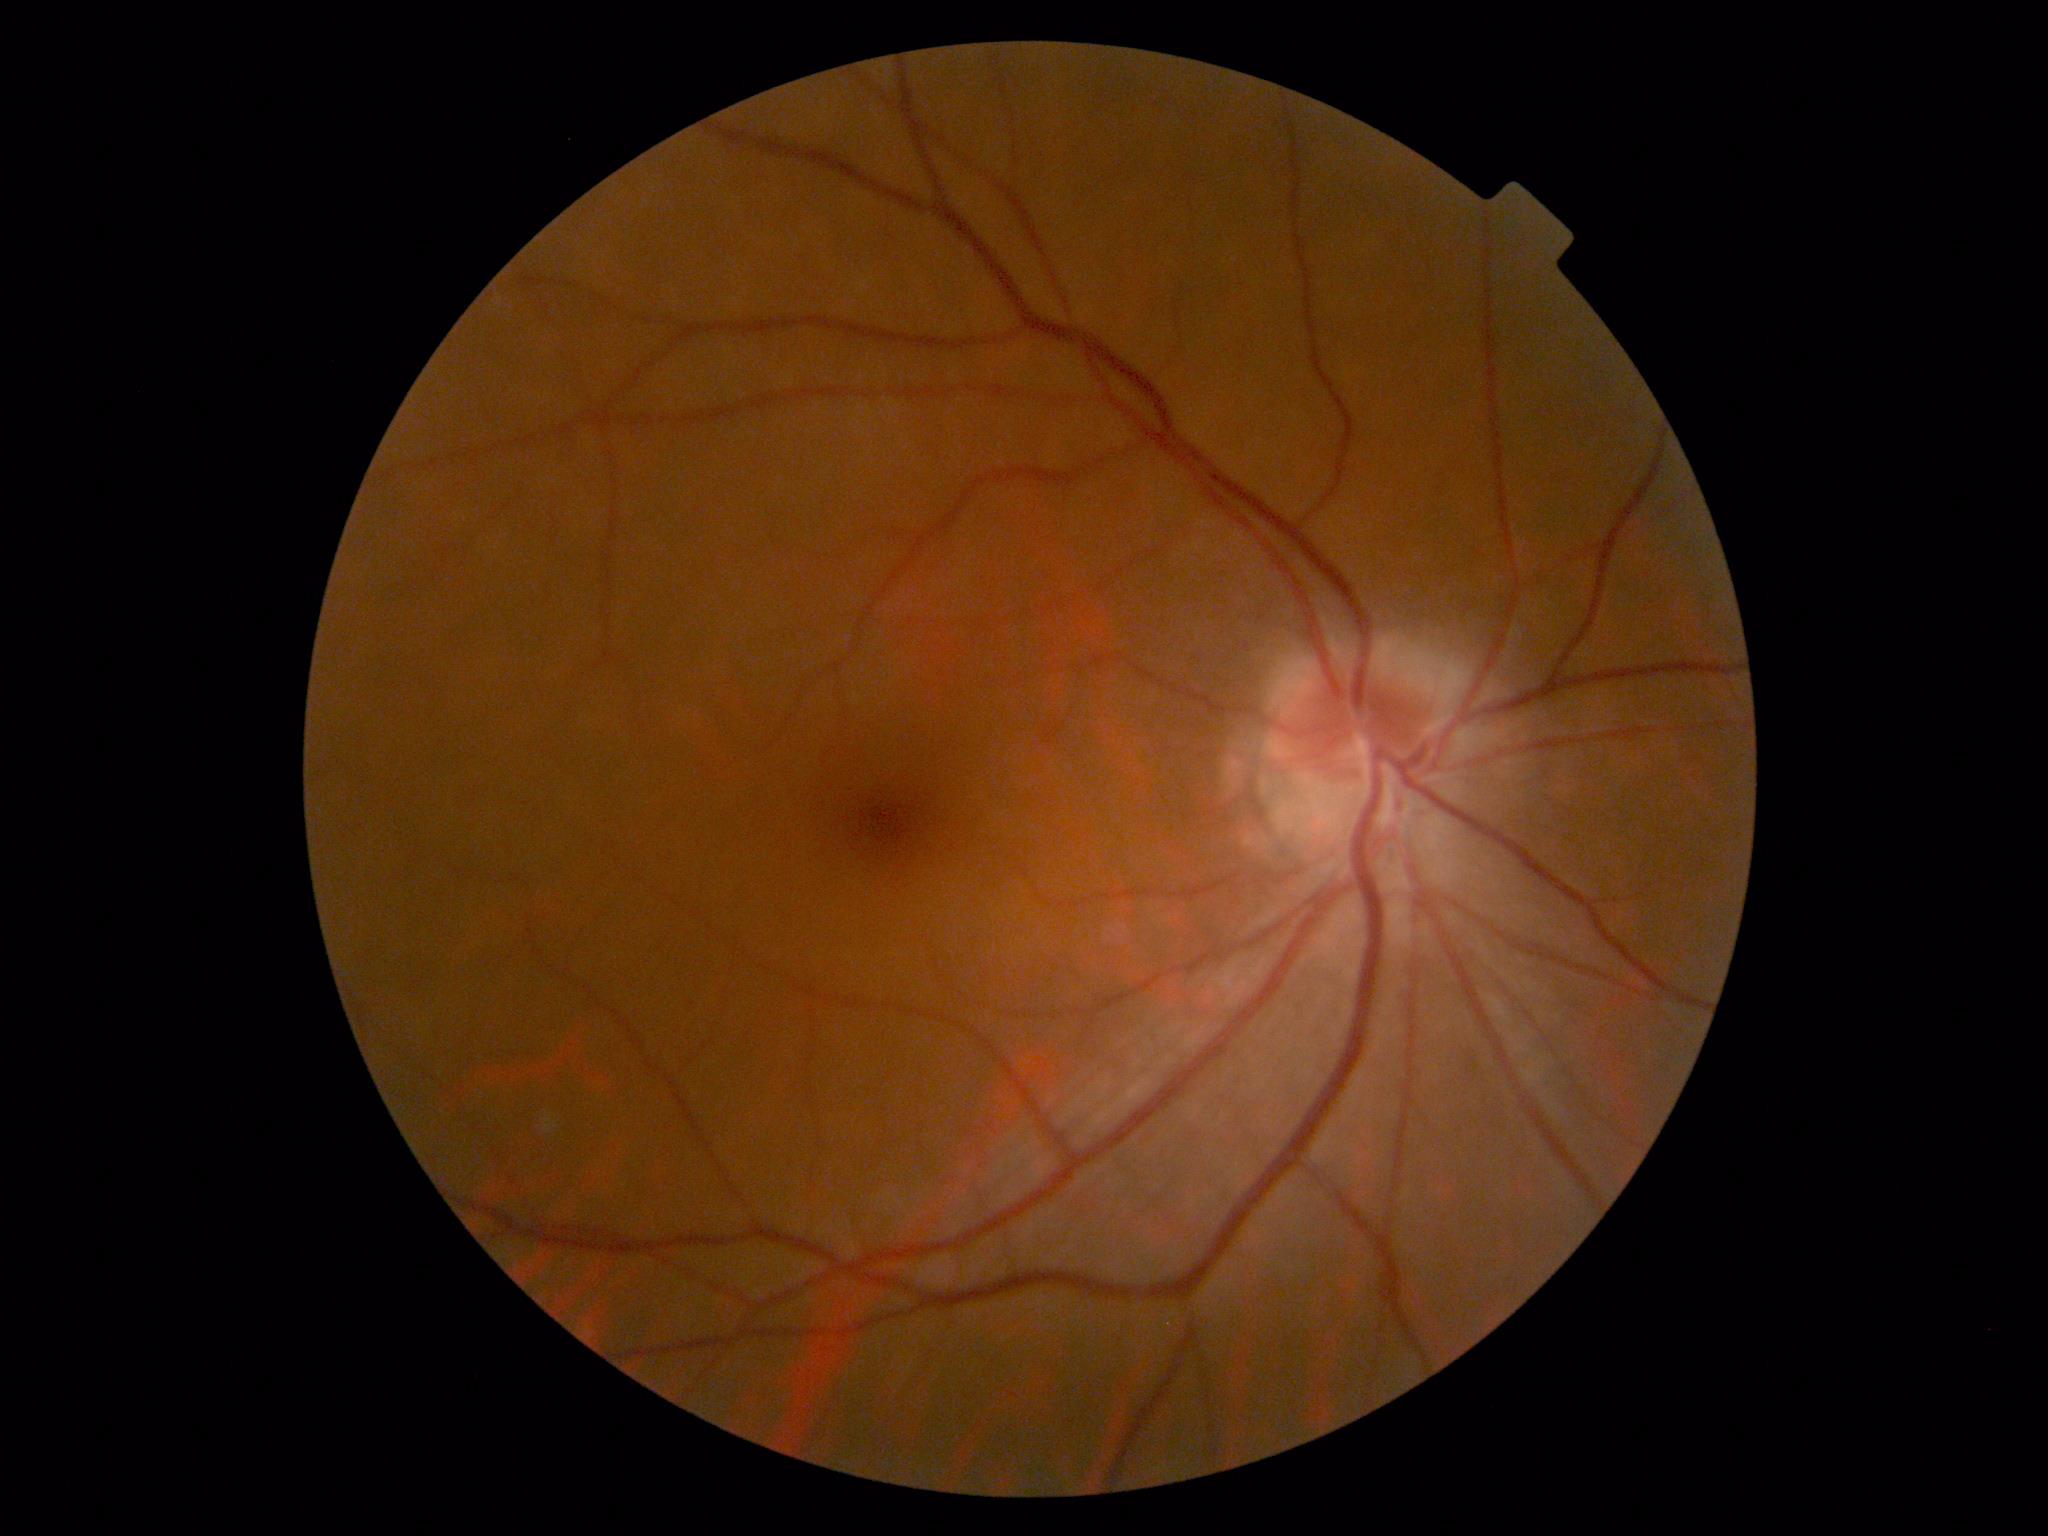 DR impression=negative for DR, diabetic retinopathy grade=no apparent diabetic retinopathy (0) — no visible signs of diabetic retinopathy.